45° FOV
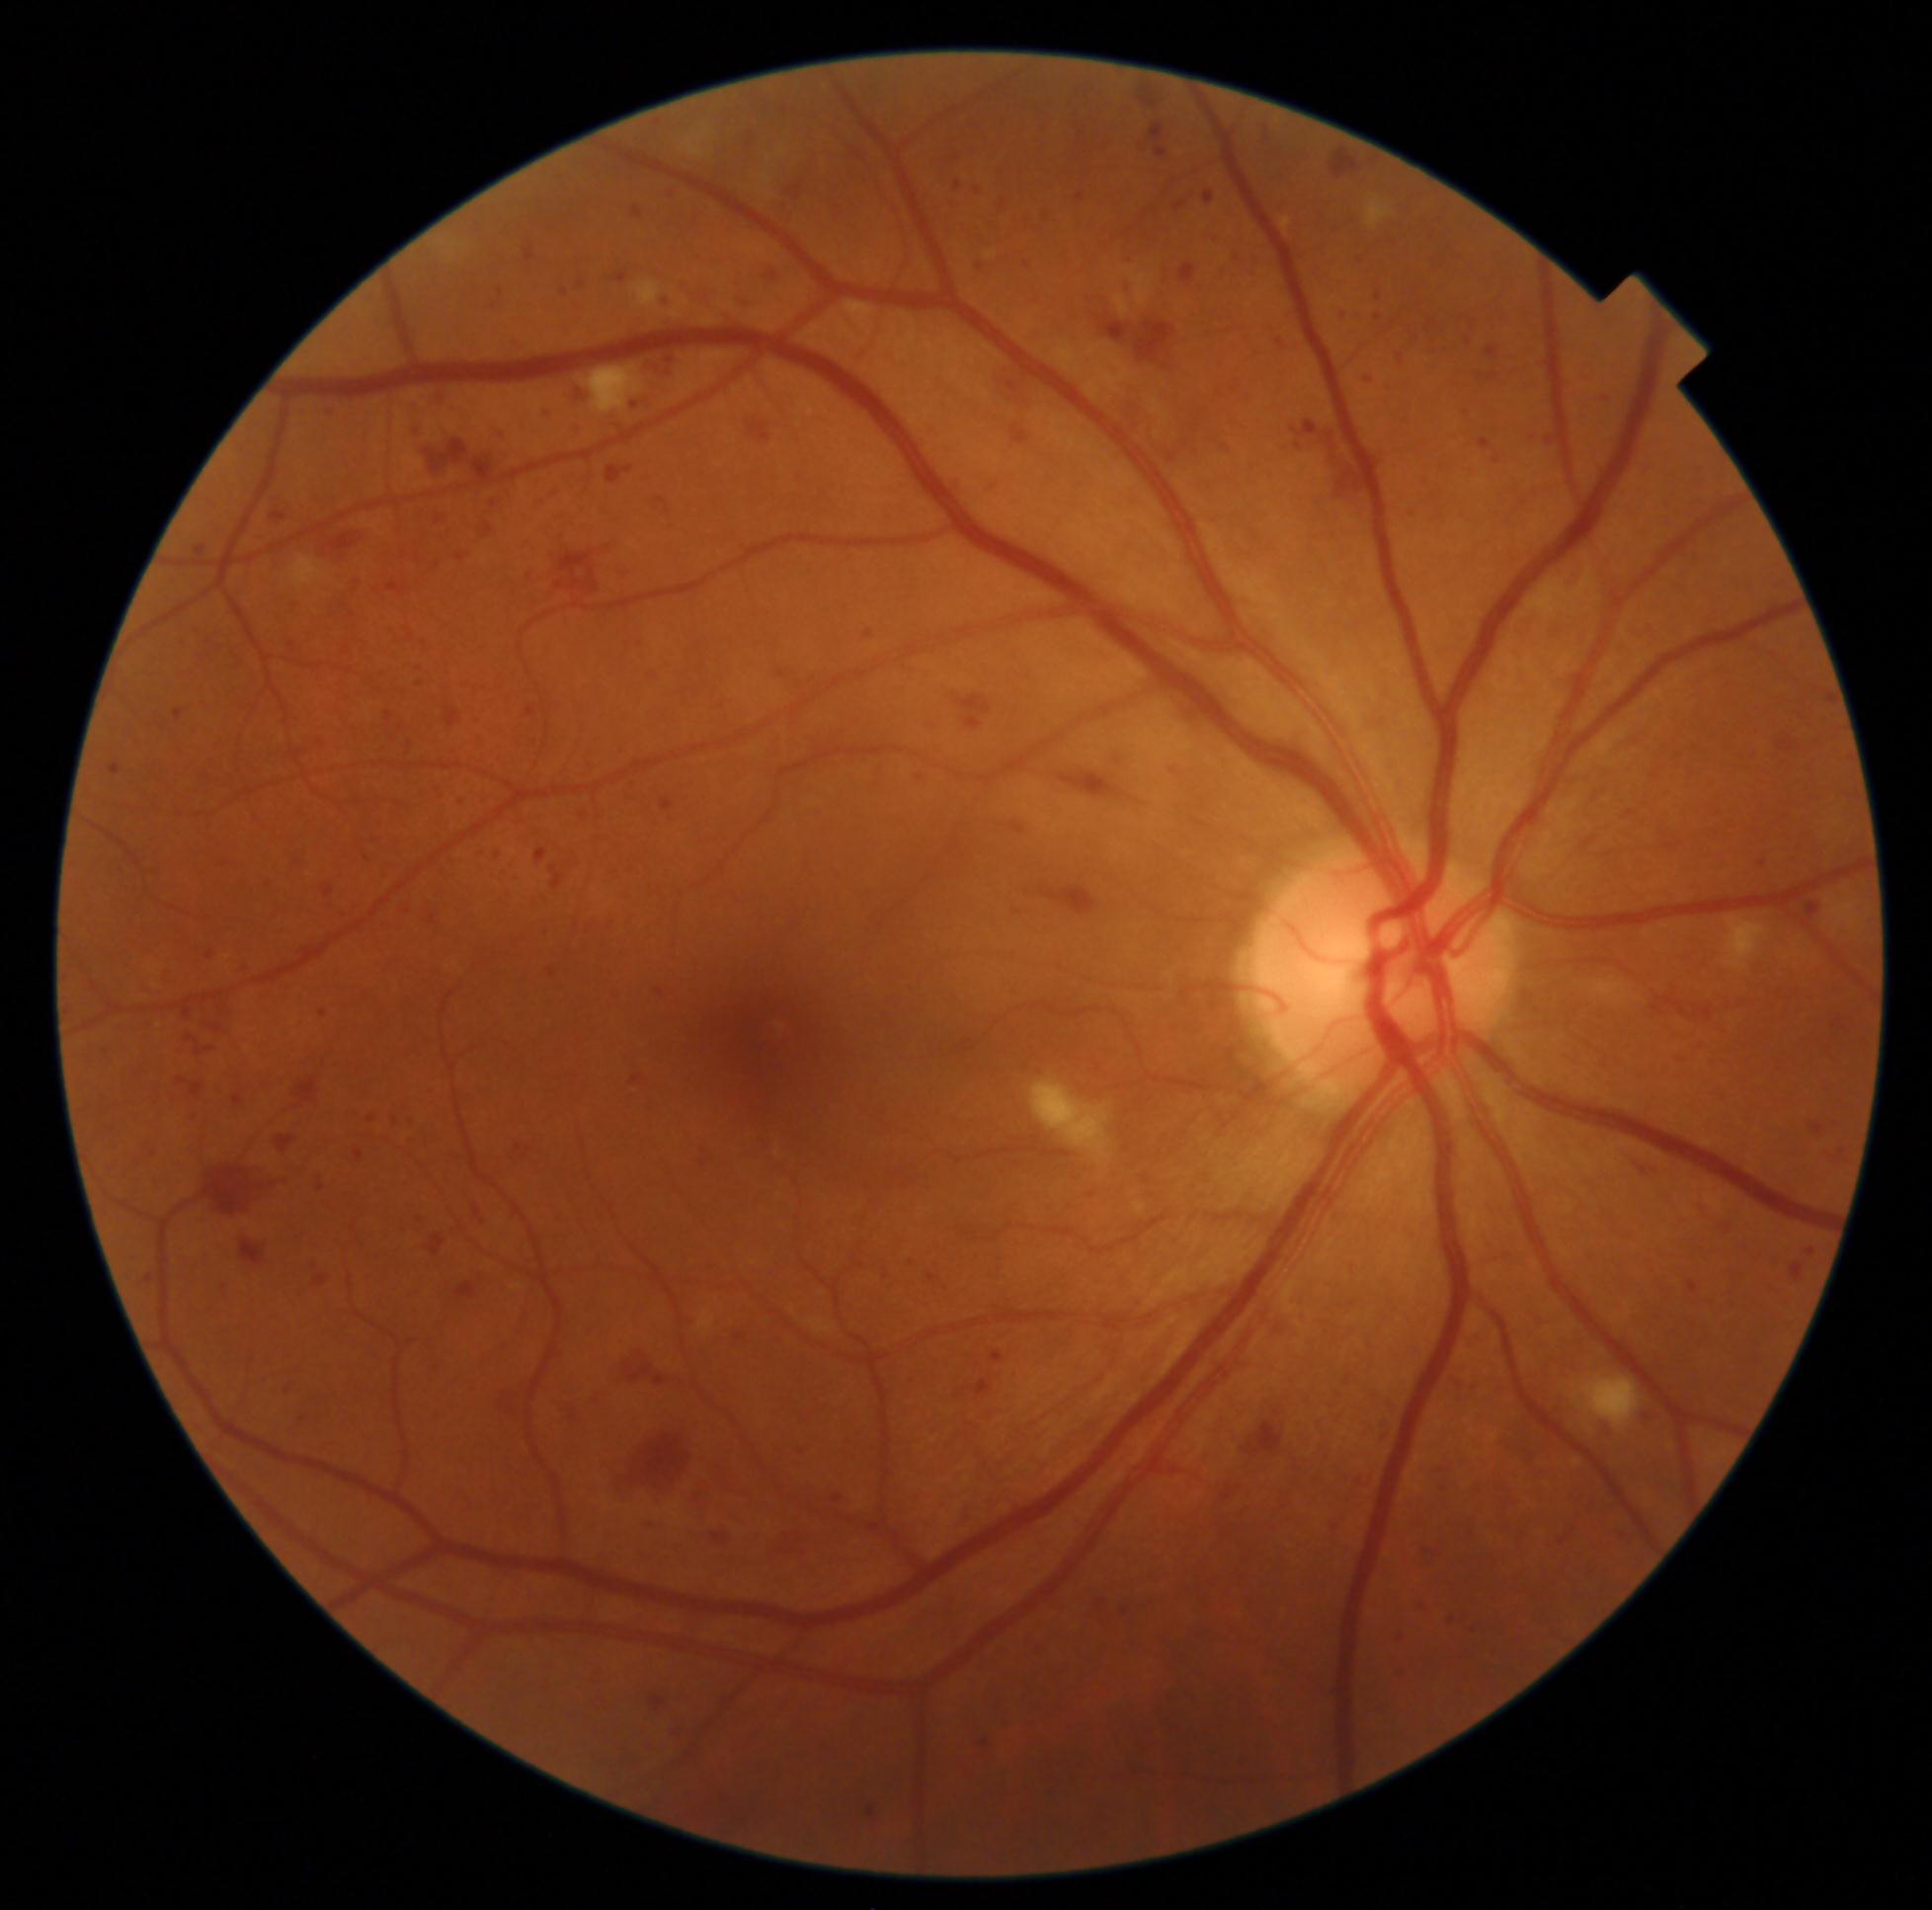 DR stage is grade 3 (severe NPDR)
Representative lesions:
HEs (continued): [1729, 1264, 1748, 1283] | [1594, 416, 1609, 428] | [1762, 647, 1779, 662] | [1198, 233, 1222, 246] | [331, 597, 358, 619] | [1435, 1480, 1450, 1495] | [1647, 987, 1729, 1040] | [1828, 693, 1837, 704] | [451, 797, 468, 806] | [793, 1440, 816, 1459] | [1428, 323, 1437, 330] | [234, 961, 254, 978] | [285, 640, 298, 655] | [511, 1142, 544, 1166] | [525, 248, 535, 262] | [769, 204, 795, 224] | [734, 1329, 750, 1347] | [548, 849, 584, 890]
HEs (small, approximate centers) near [x=1403, y=1638] | [x=1482, y=376]